Retinal fundus photograph — 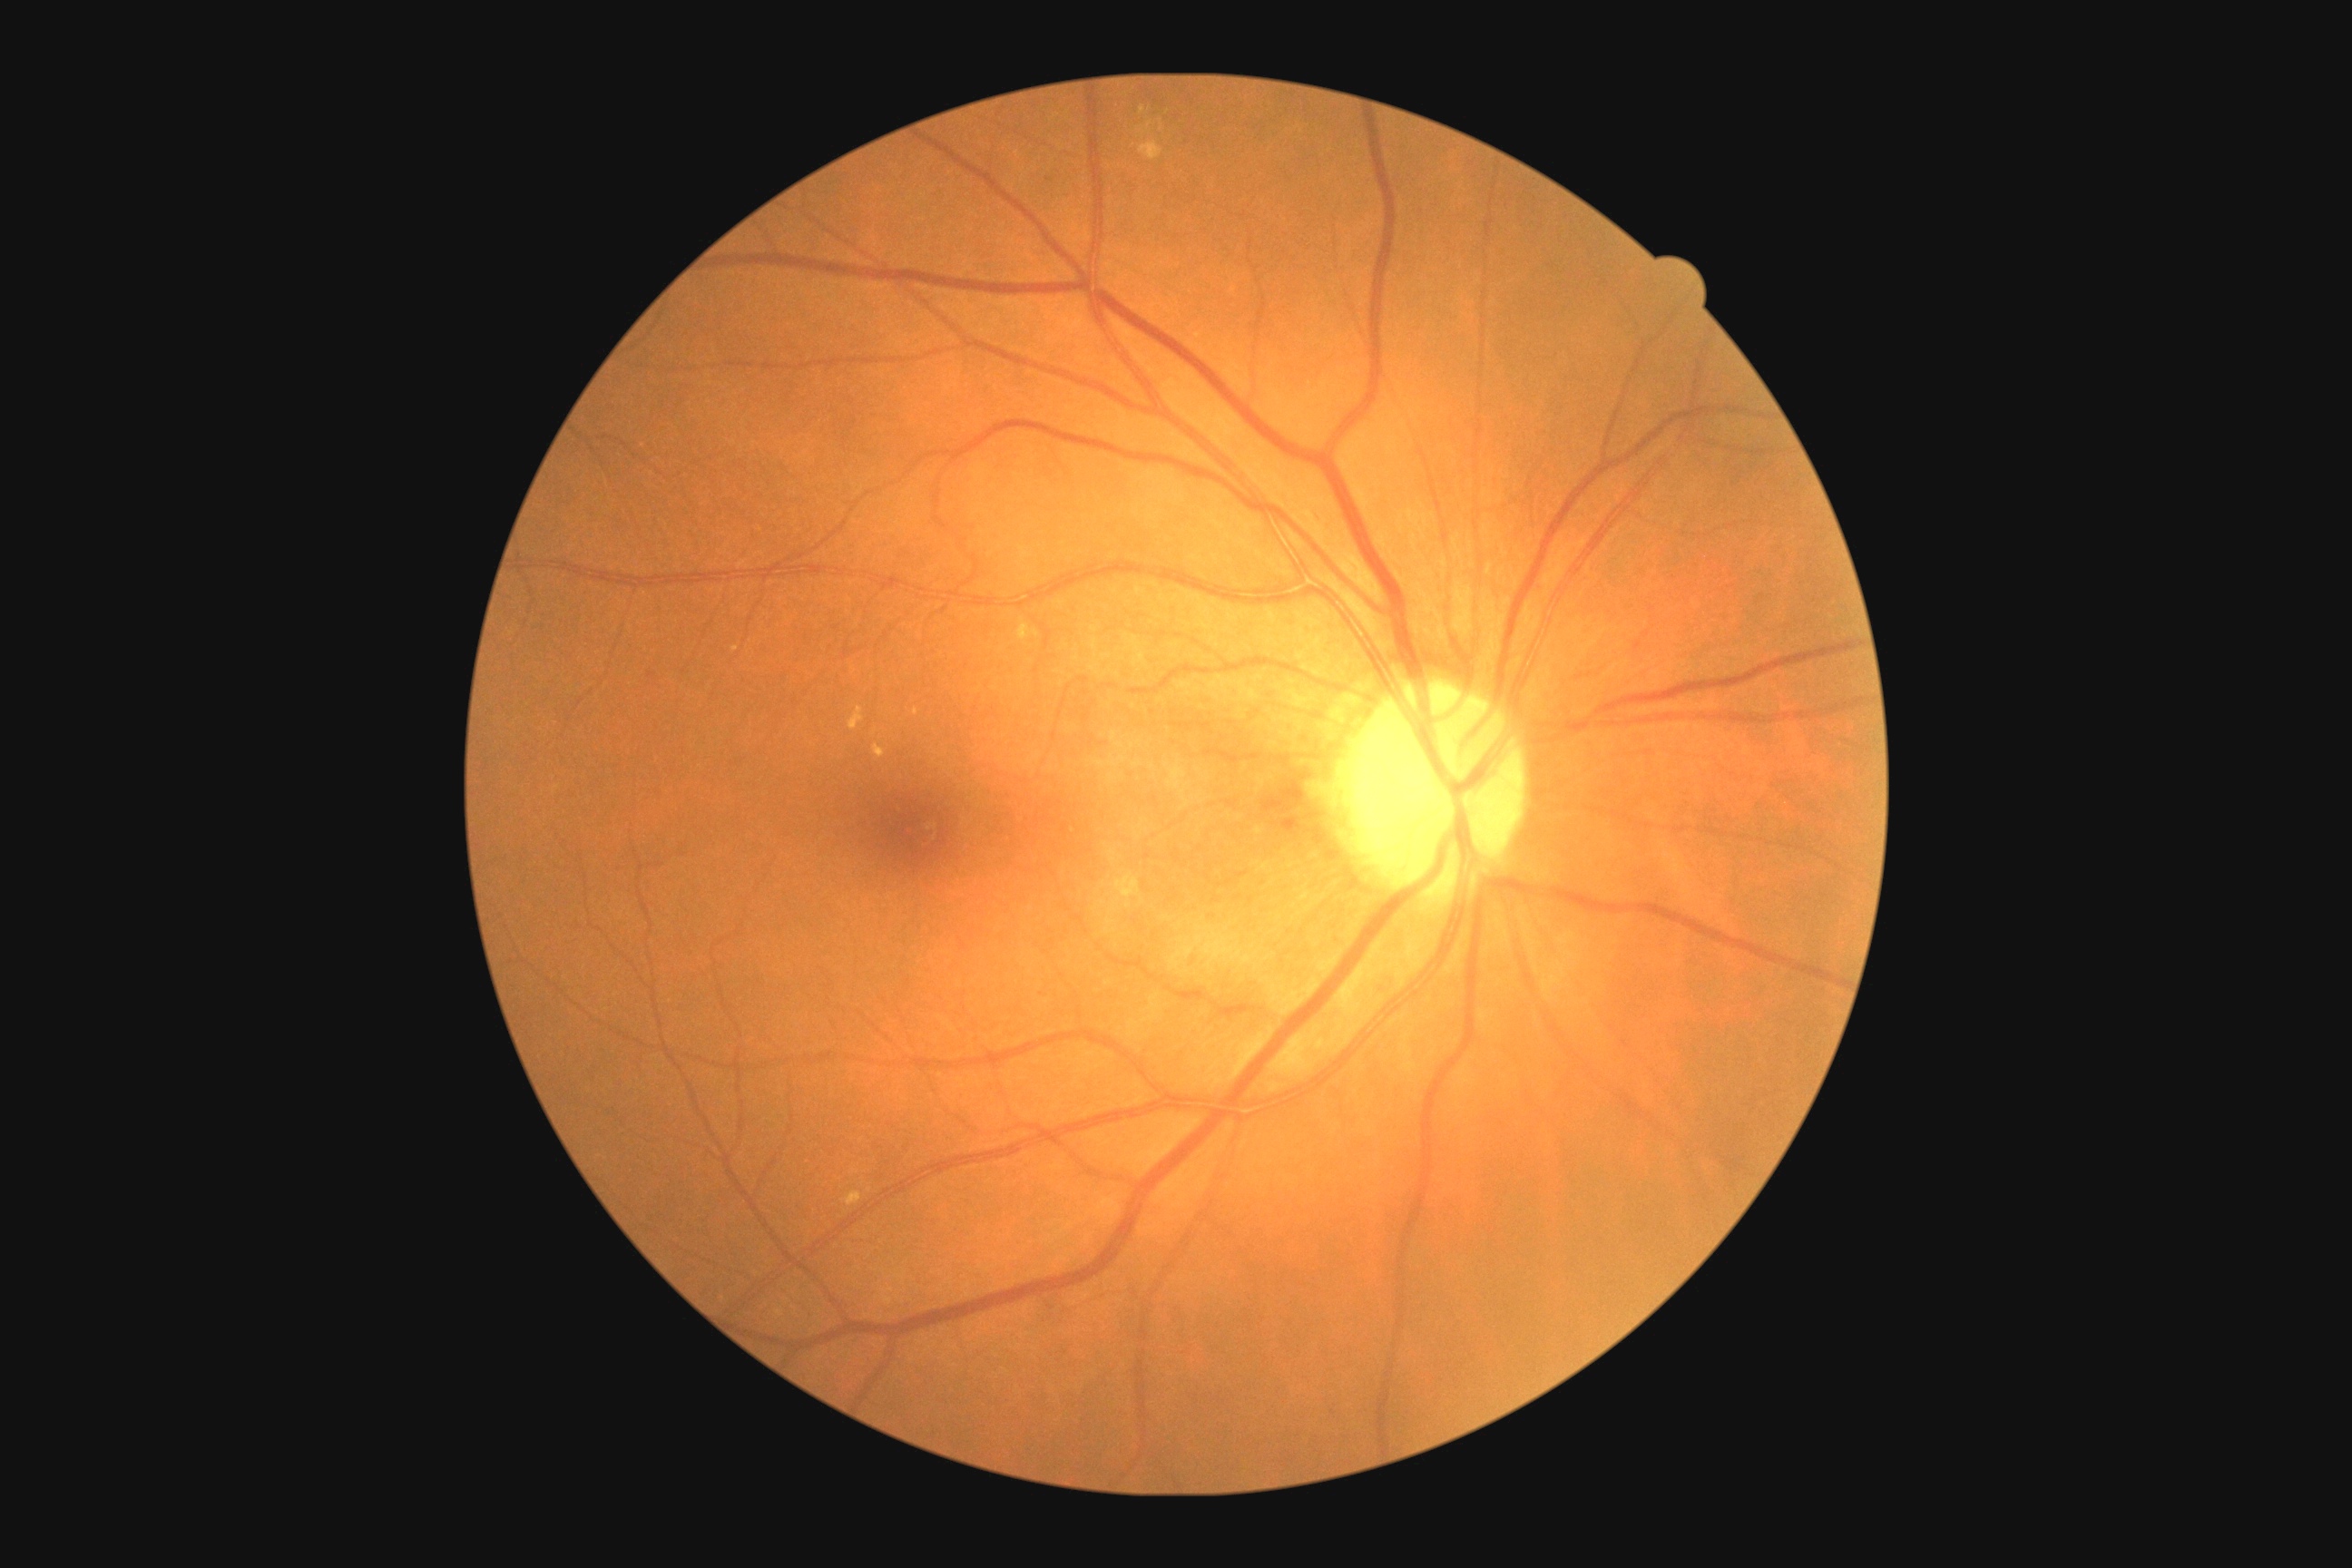

Diabetic retinopathy (DR) is 2/4.